45-degree field of view · 2048x1536px
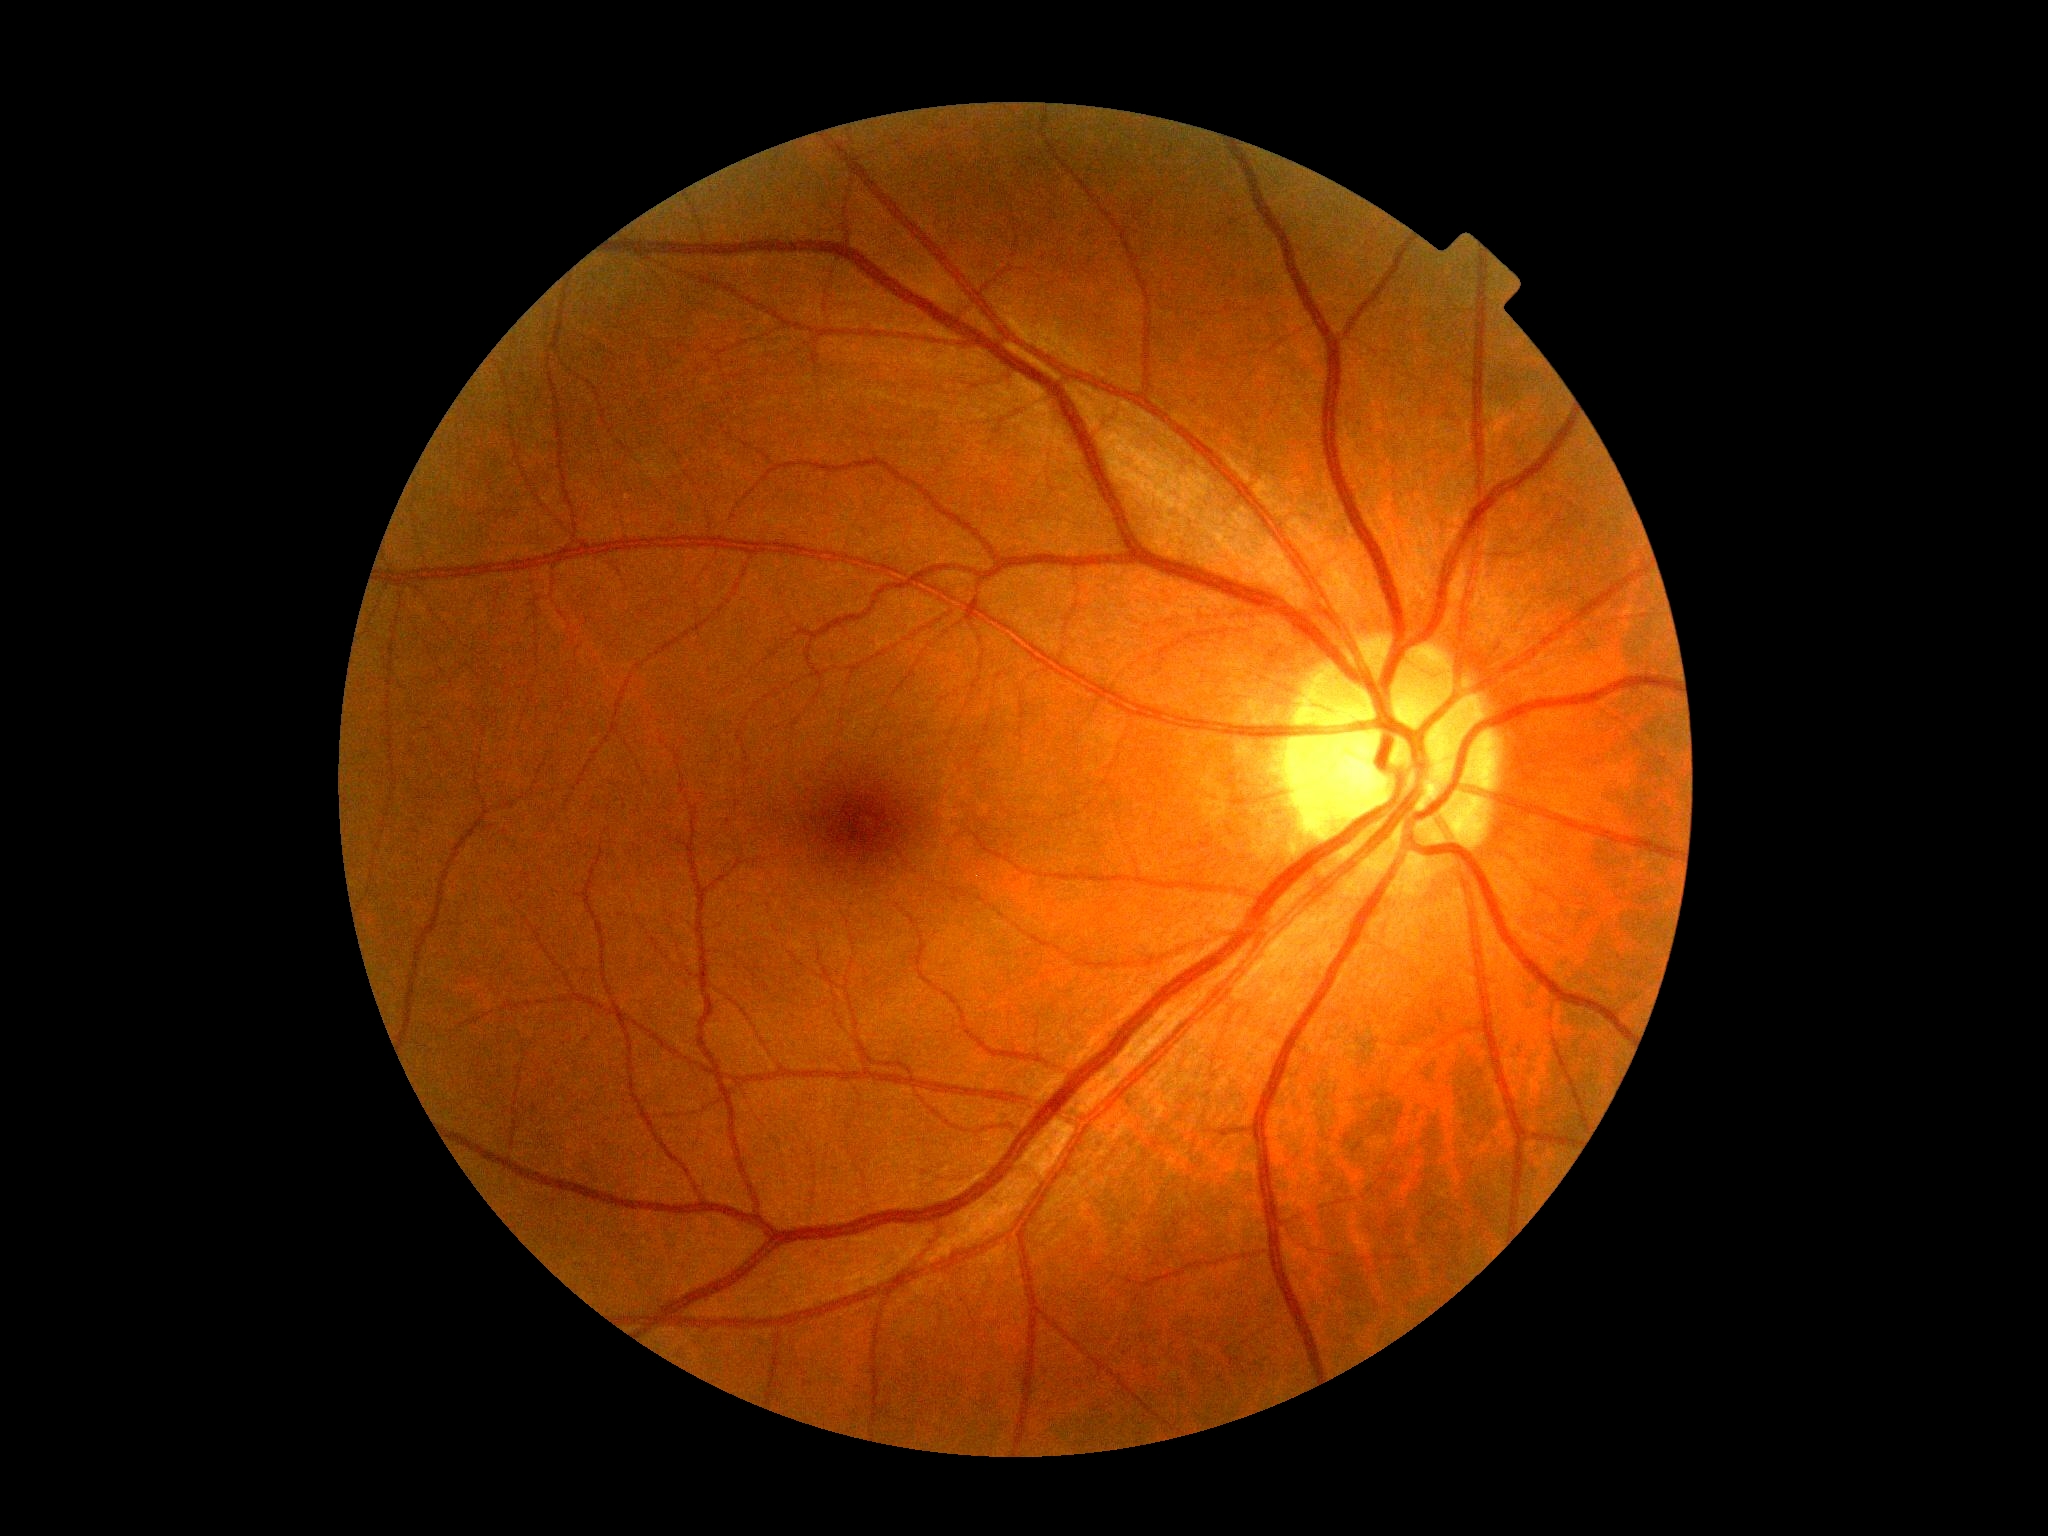
dr_impression: no apparent DR
dr_grade: 0/4 — no visible signs of diabetic retinopathy